Modified Davis classification.
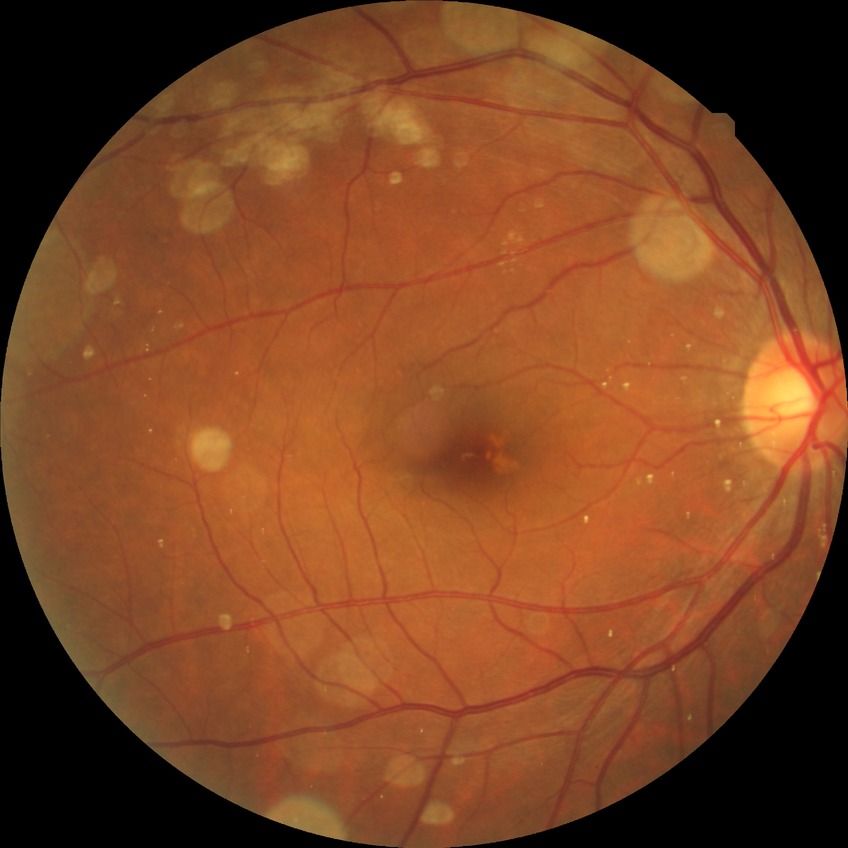

Modified Davis classification: no diabetic retinopathy.